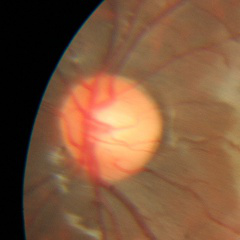
No glaucoma.